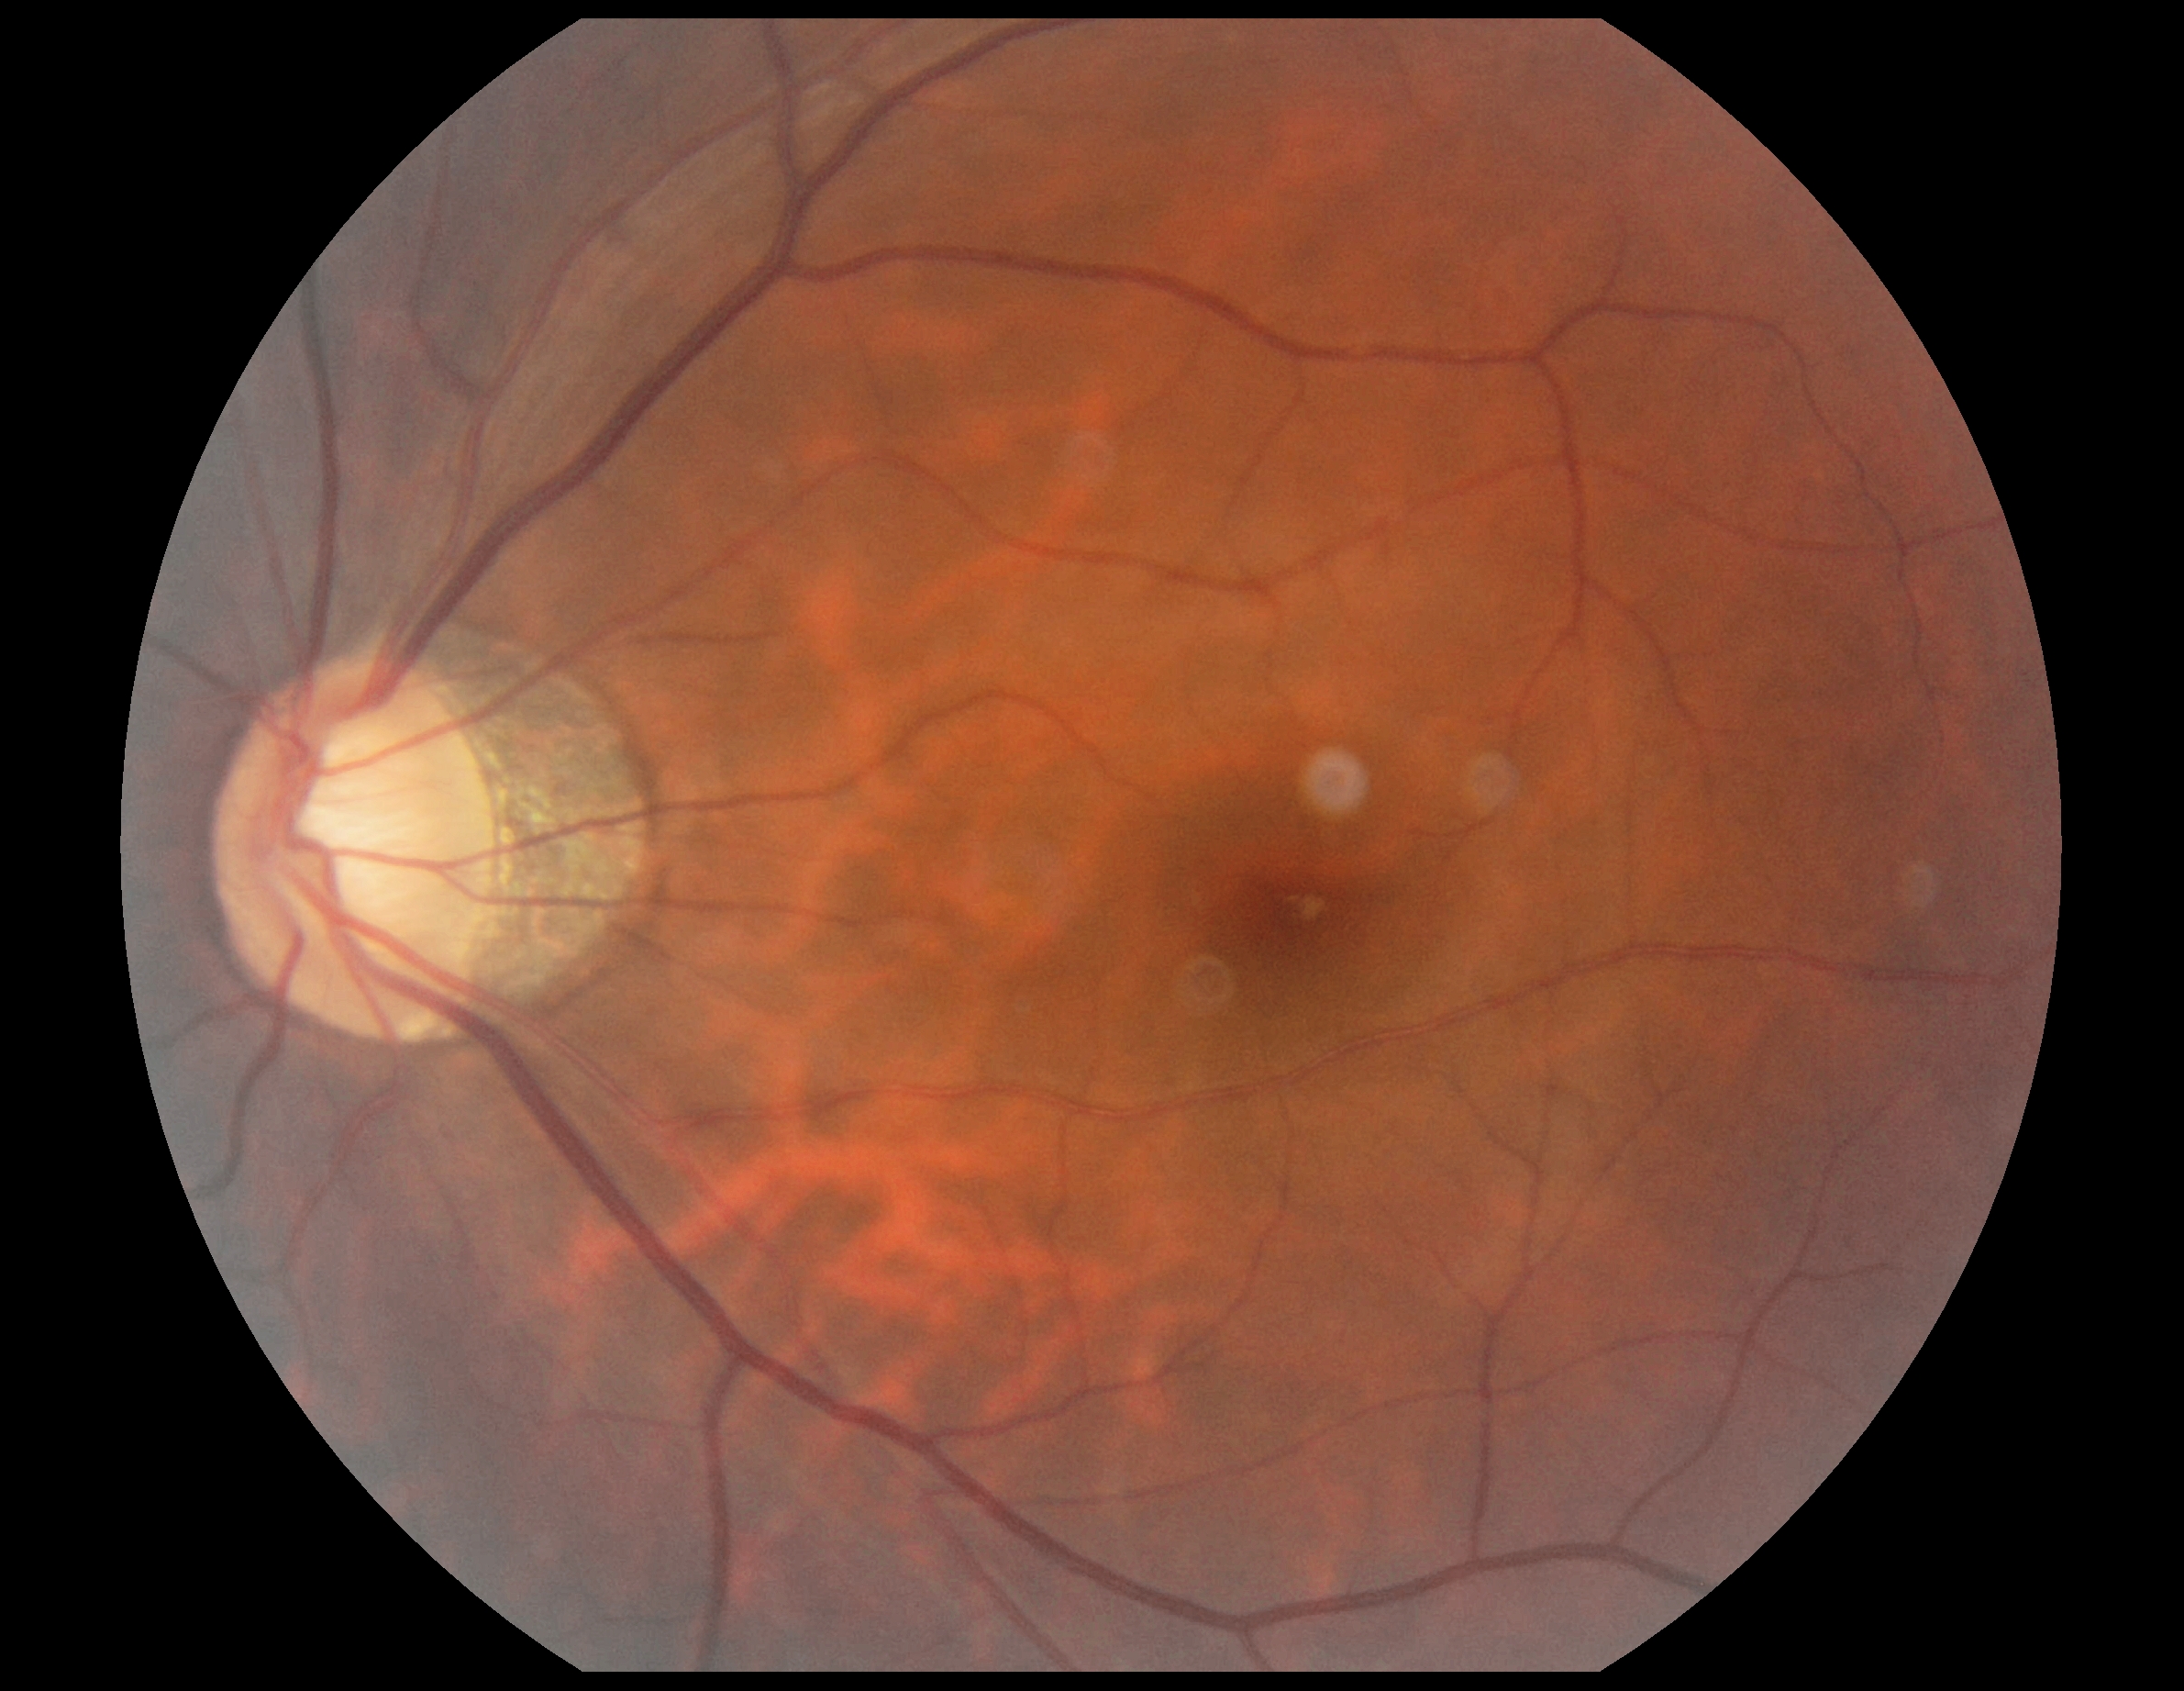

retinopathy: grade 0 (no apparent retinopathy), DR impression: no apparent DR.